Pediatric retinal photograph (wide-field).
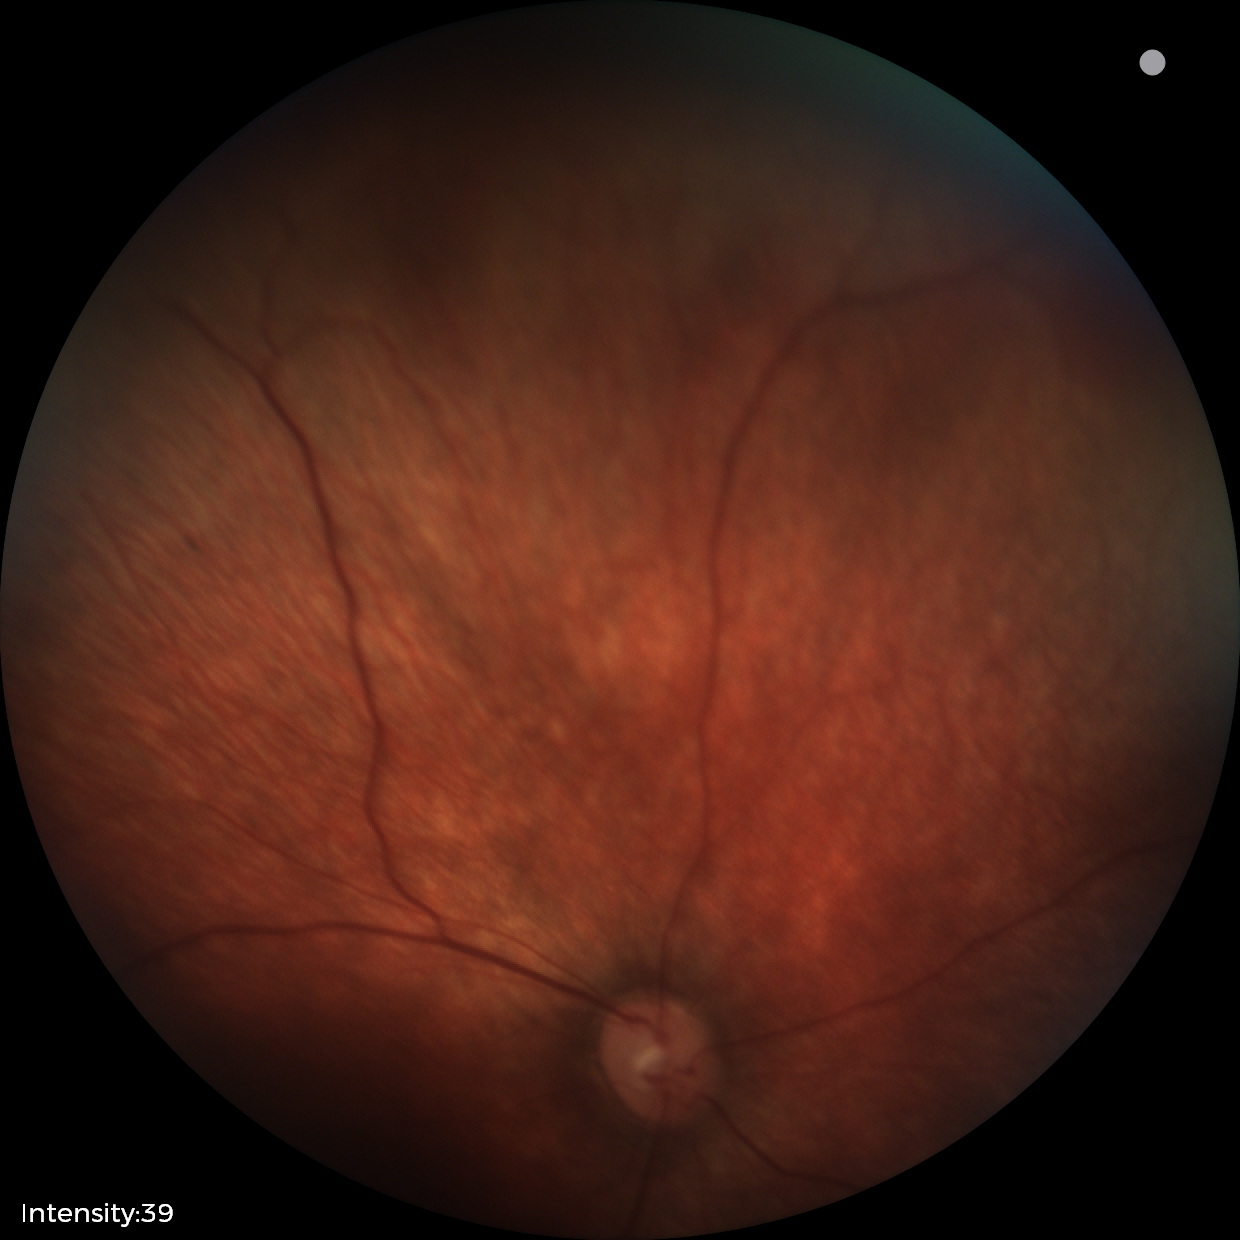

Q: What is the screening diagnosis?
A: normal retinal appearance